Infant wide-field retinal image; acquired on the Clarity RetCam 3.
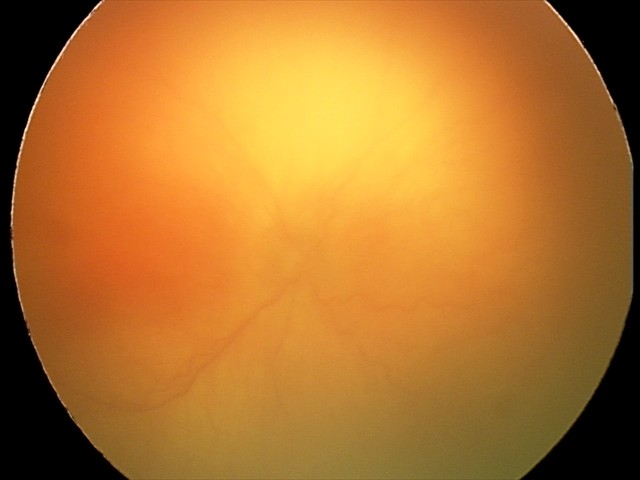

Plus disease: present, finding: aggressive retinopathy of prematurity.